Dilated-pupil acquisition:
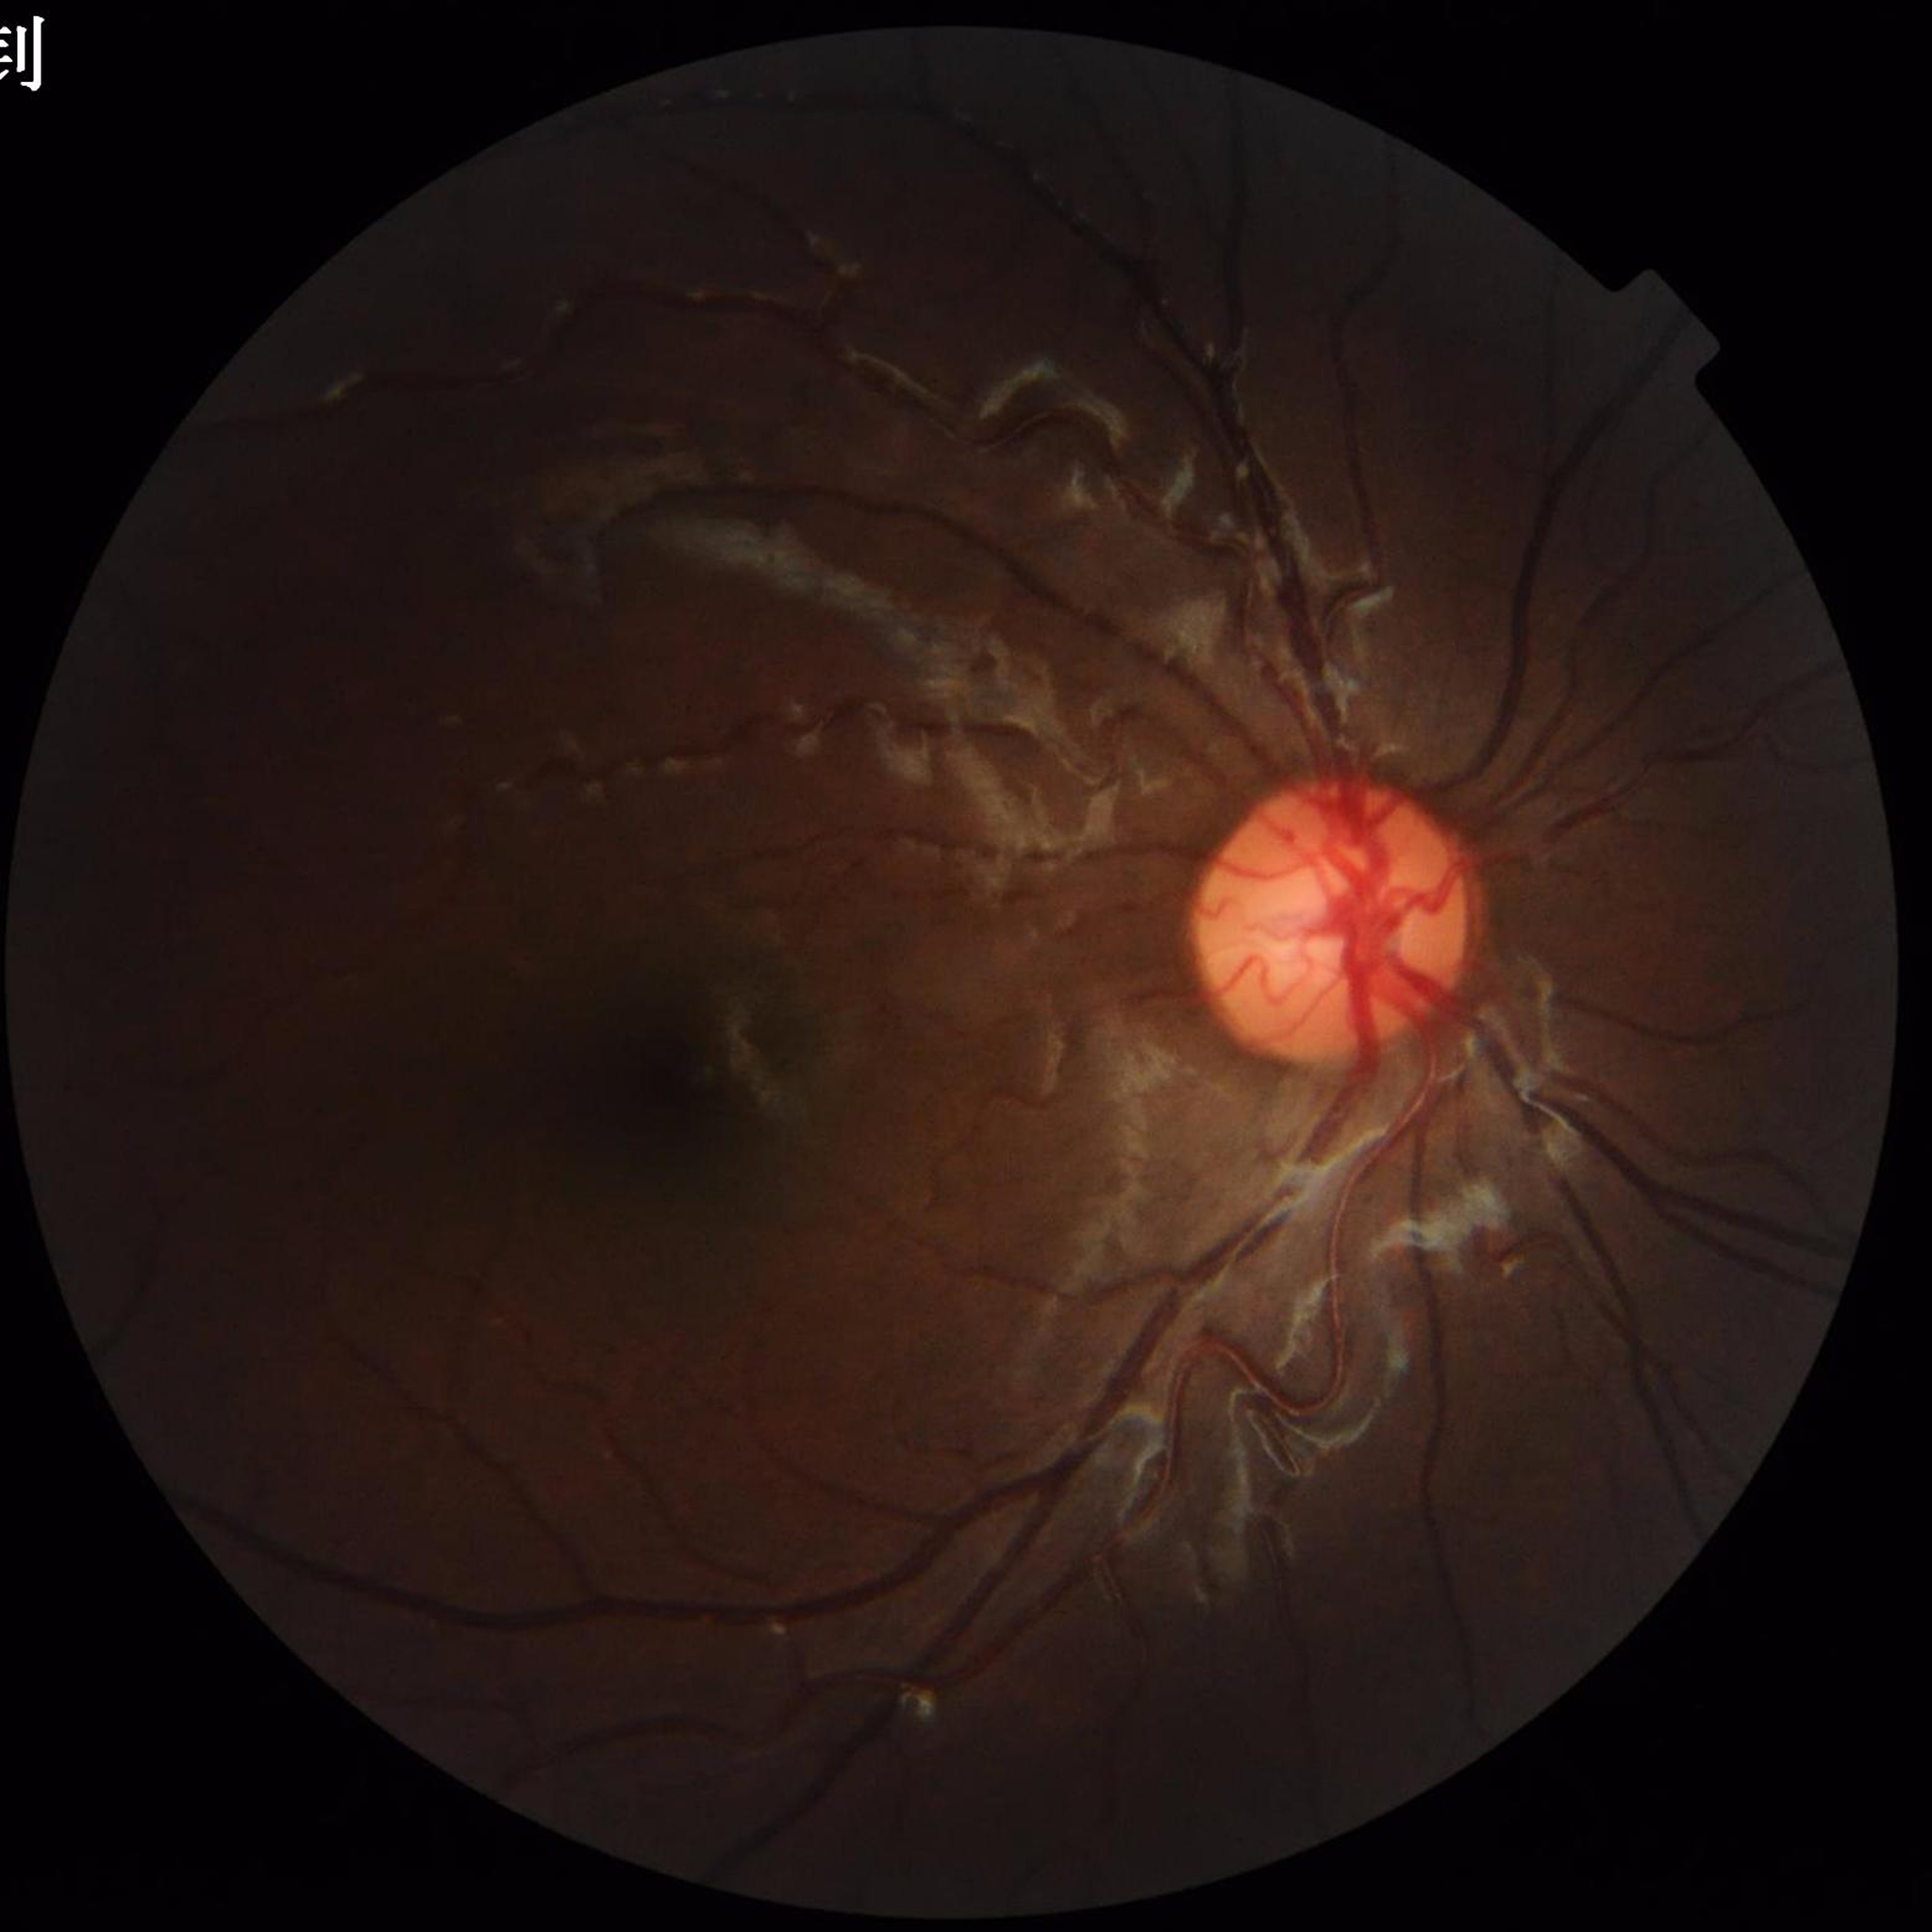
Color fundus photograph with no signs of AMD, diabetic retinopathy, or glaucoma.